ONH-centered crop from a color fundus image — 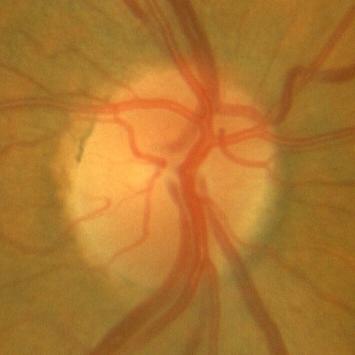

Impression = no glaucoma.